1440 by 1080 pixels. RetCam wide-field infant fundus image. 130° field of view (Natus RetCam Envision):
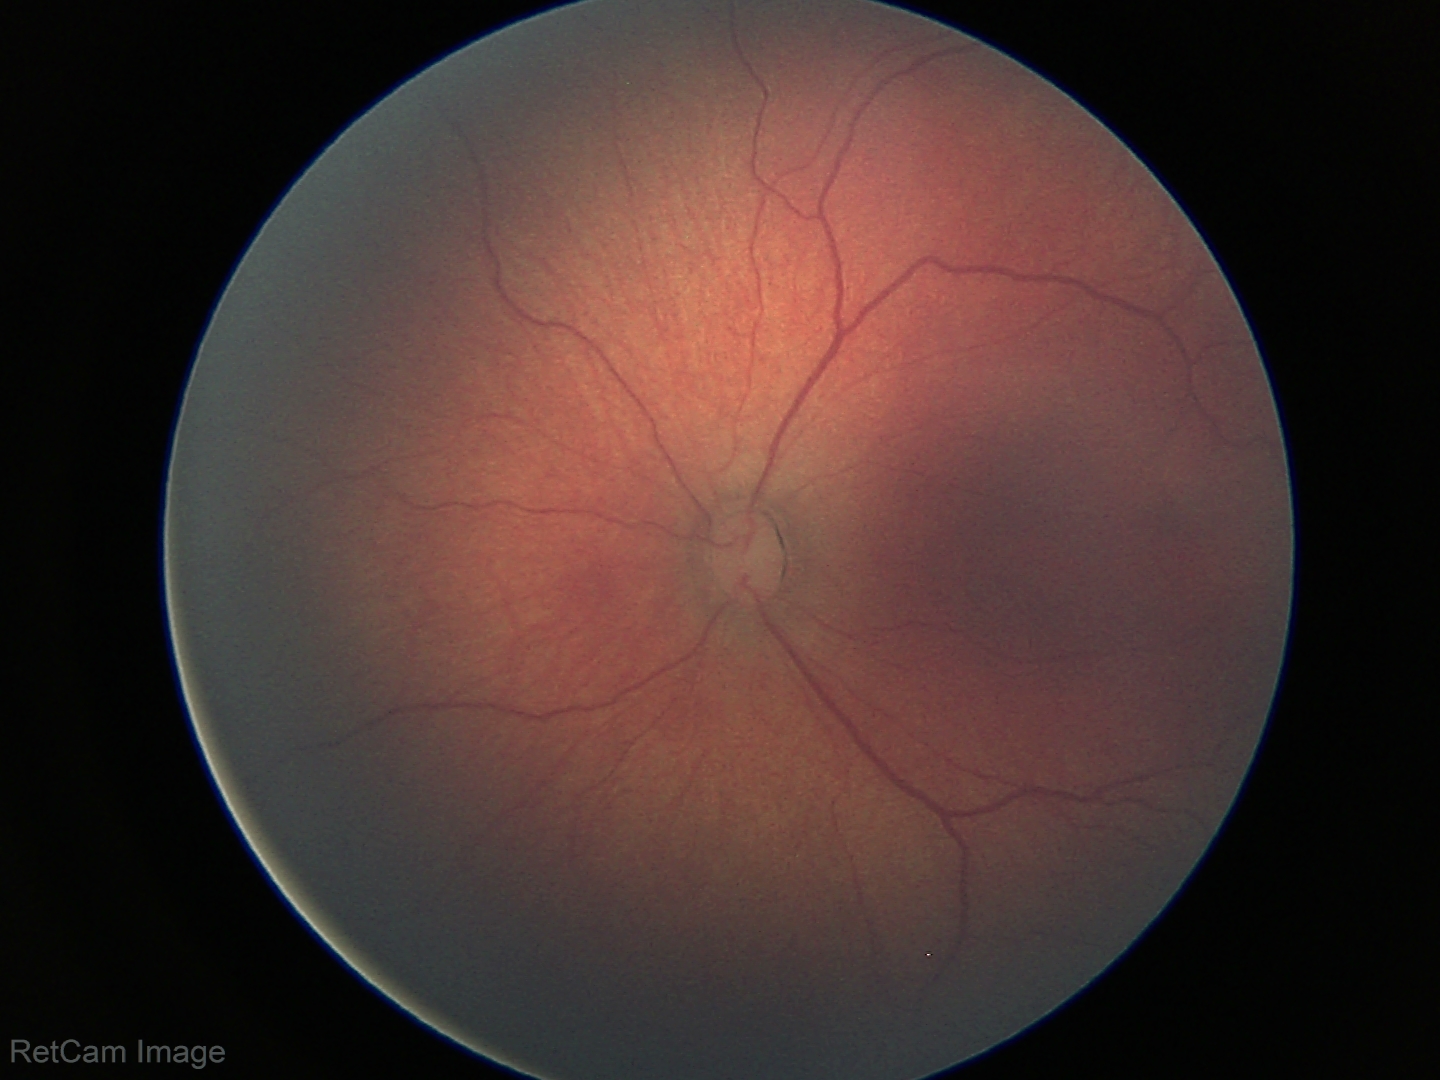

Without plus disease.
Screening series with retinopathy of prematurity stage 2 — ridge with height and width at the demarcation line.